45° field of view: 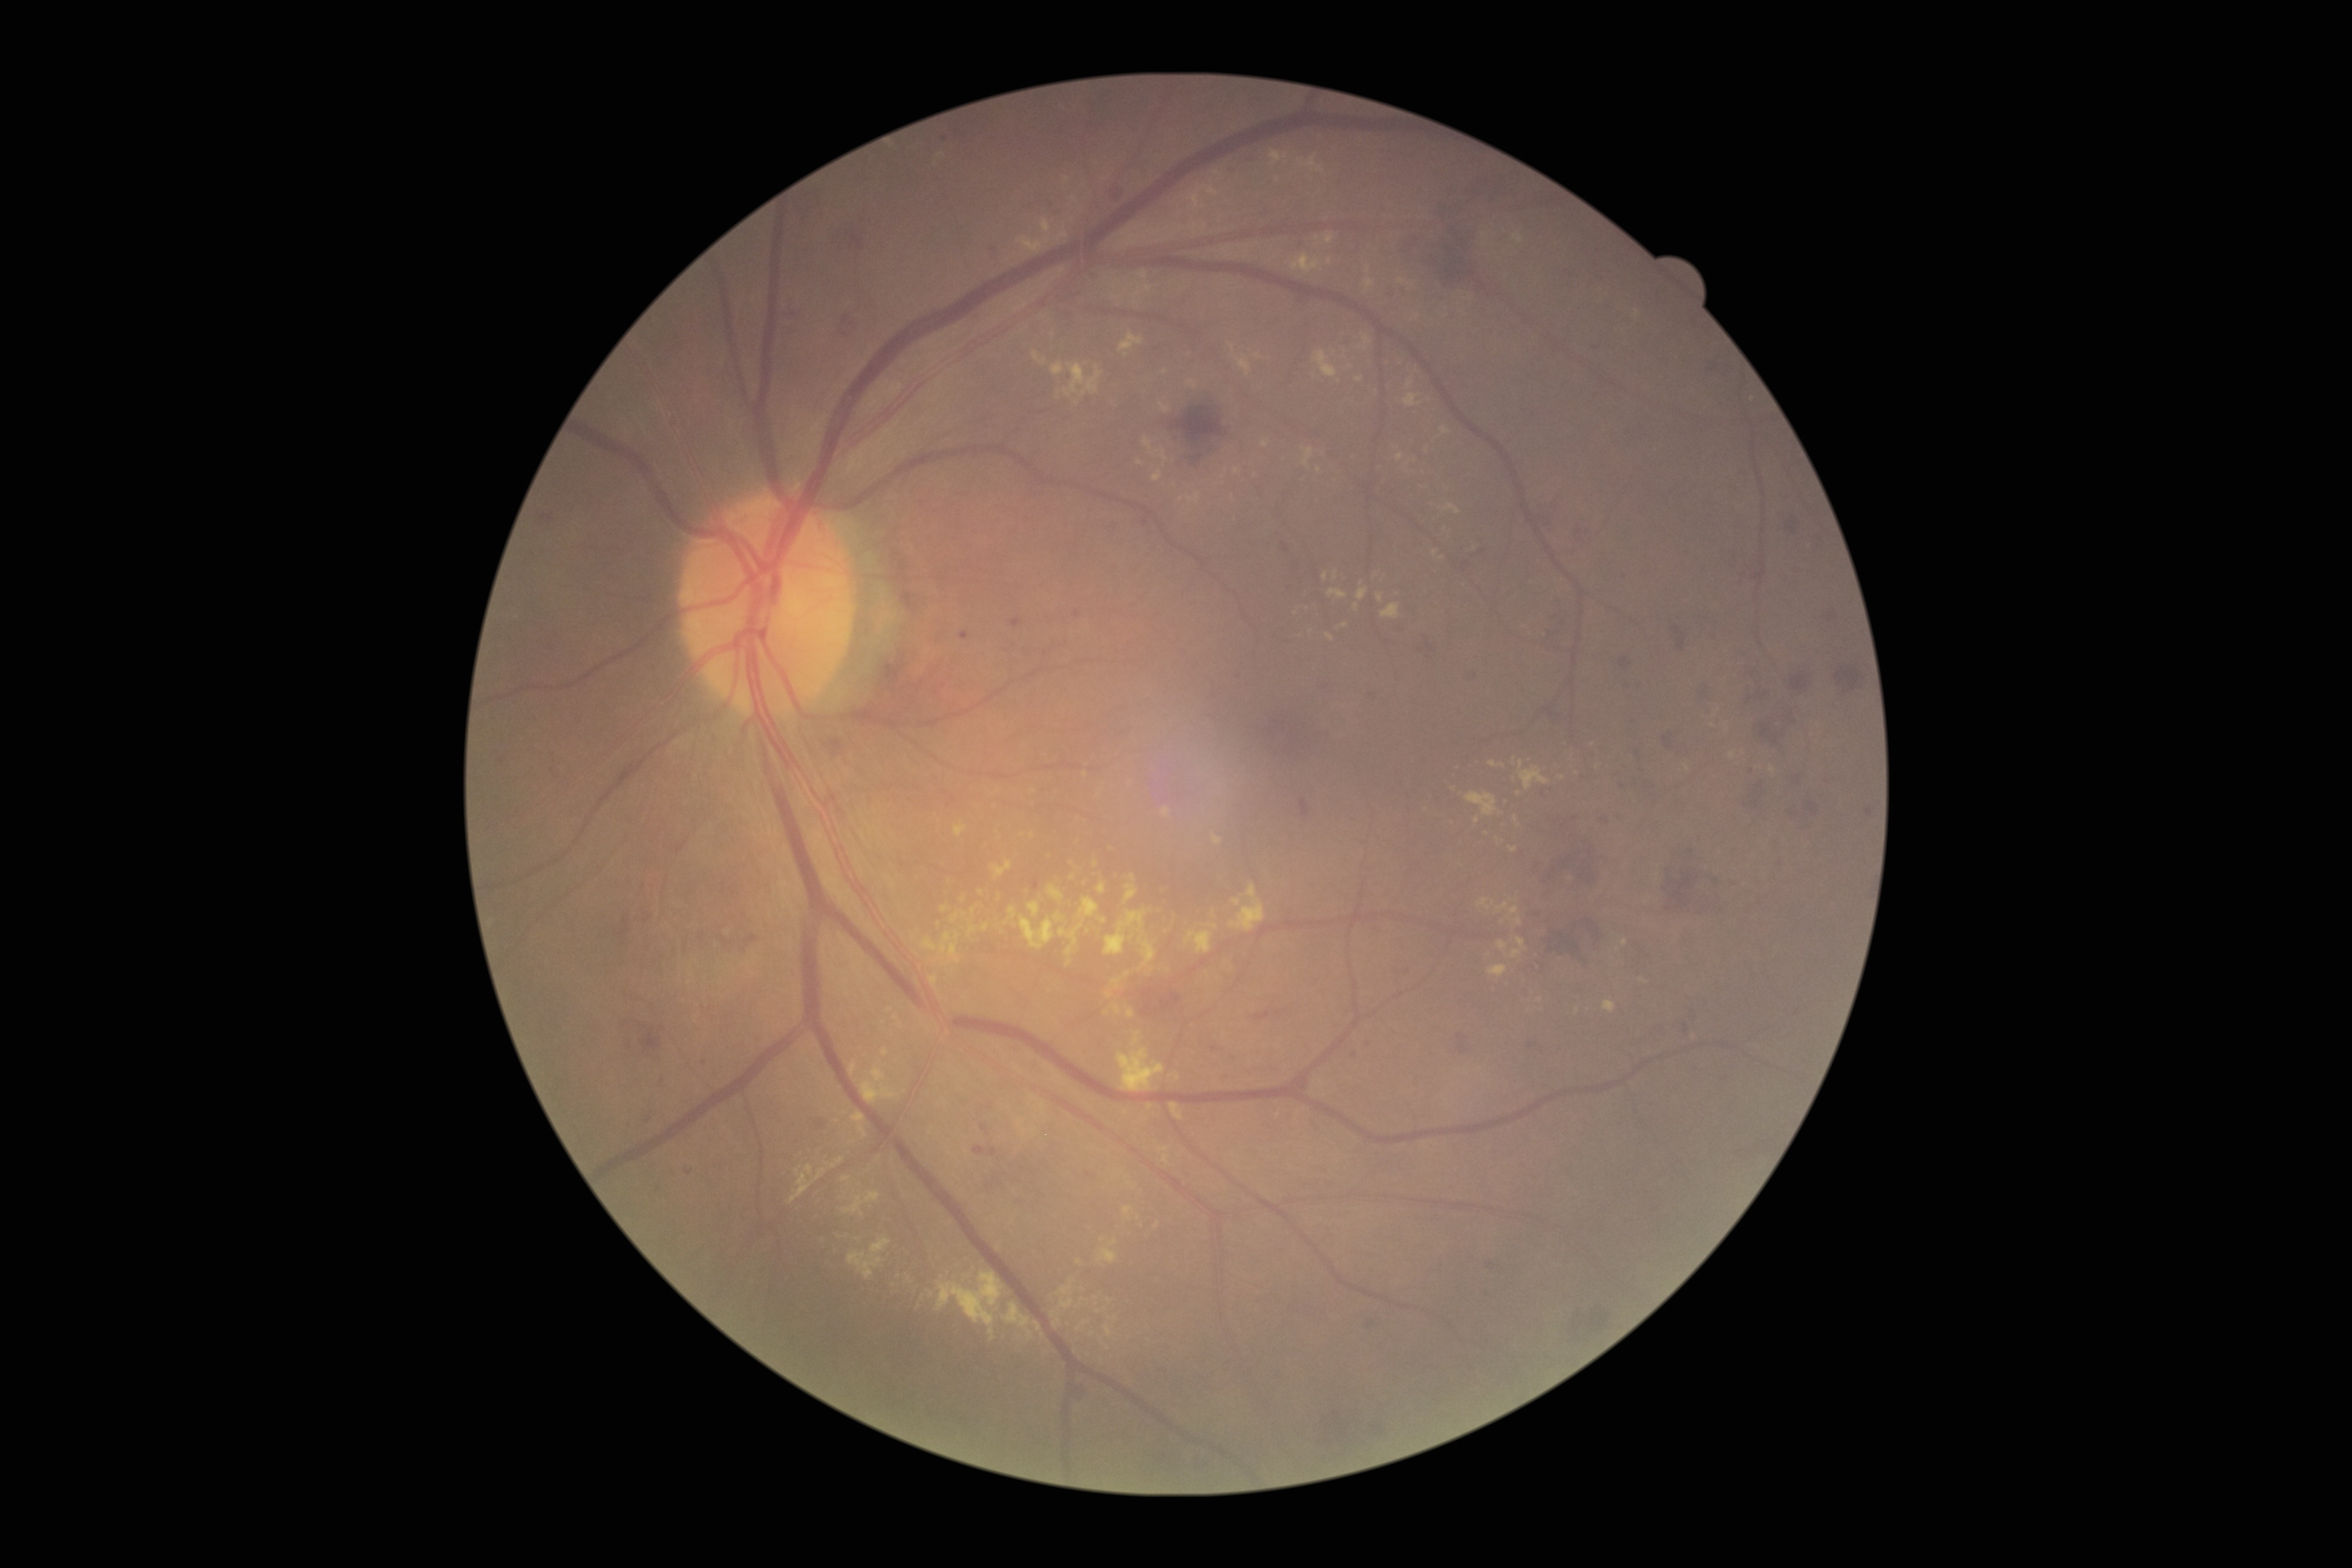

DR is moderate non-proliferative diabetic retinopathy (grade 2)
Selected lesions:
- HEs (more not shown): box(539, 515, 554, 524) | box(1667, 863, 1719, 913) | box(1675, 627, 1686, 650) | box(1471, 549, 1485, 560) | box(1710, 355, 1723, 372) | box(1771, 833, 1782, 849) | box(840, 315, 856, 333) | box(1621, 656, 1632, 668) | box(777, 308, 794, 320) | box(1550, 610, 1560, 619) | box(1753, 666, 1769, 699) | box(1161, 991, 1181, 1011) | box(1427, 644, 1434, 653) | box(1440, 176, 1489, 211) | box(1663, 737, 1673, 748) | box(1823, 612, 1836, 621)
- Smaller HEs around (1560, 604)
- EXs (more not shown): box(1466, 792, 1498, 816) | box(1054, 913, 1064, 923) | box(1440, 426, 1450, 435) | box(831, 1157, 844, 1168) | box(1445, 503, 1461, 515) | box(1116, 1047, 1165, 1092) | box(1160, 403, 1171, 414) | box(1047, 885, 1064, 902) | box(1728, 751, 1736, 759) | box(1519, 759, 1524, 769) | box(1298, 155, 1325, 175)
- Smaller EXs around (1350, 367) | (1427, 451) | (1277, 180) | (1369, 270) | (1177, 1078) | (1067, 180) | (1597, 767) | (1043, 1335)